Captured after pupil dilation:
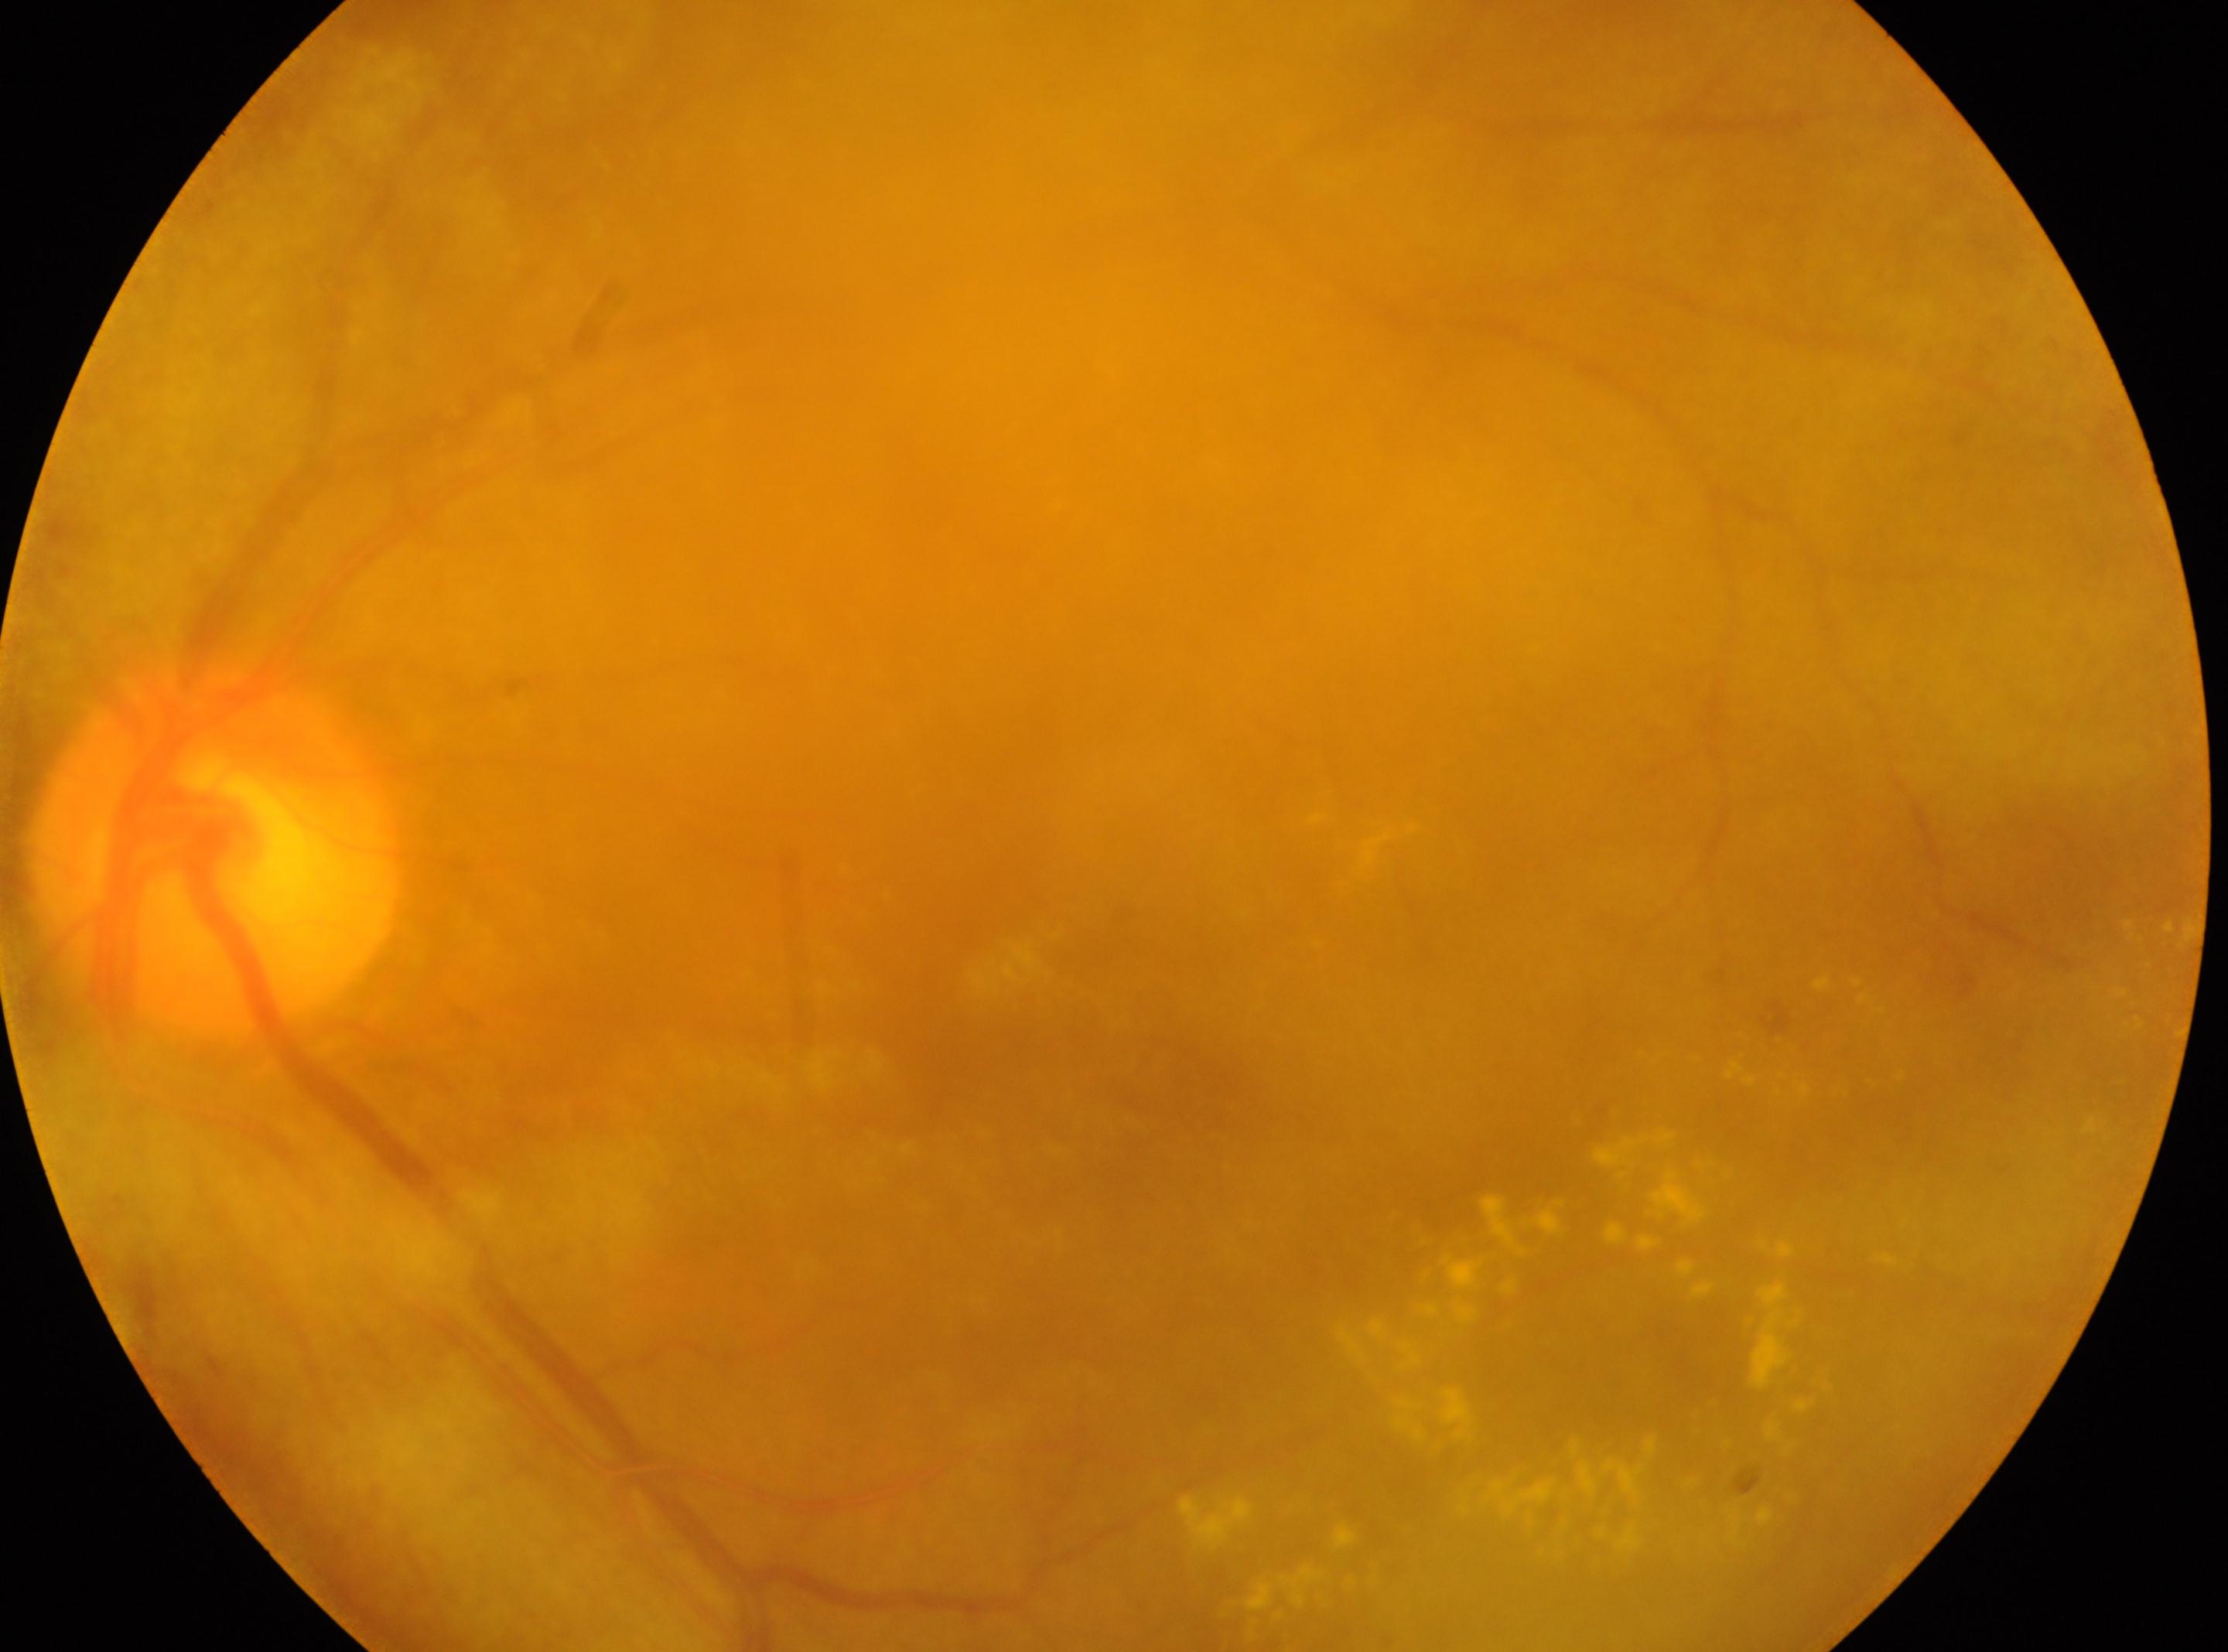

DR: moderate non-proliferative diabetic retinopathy (grade 2). The image shows the left eye. Fovea located at 1010, 1032. The disc center is at 218, 845.